UWF retinal mosaic
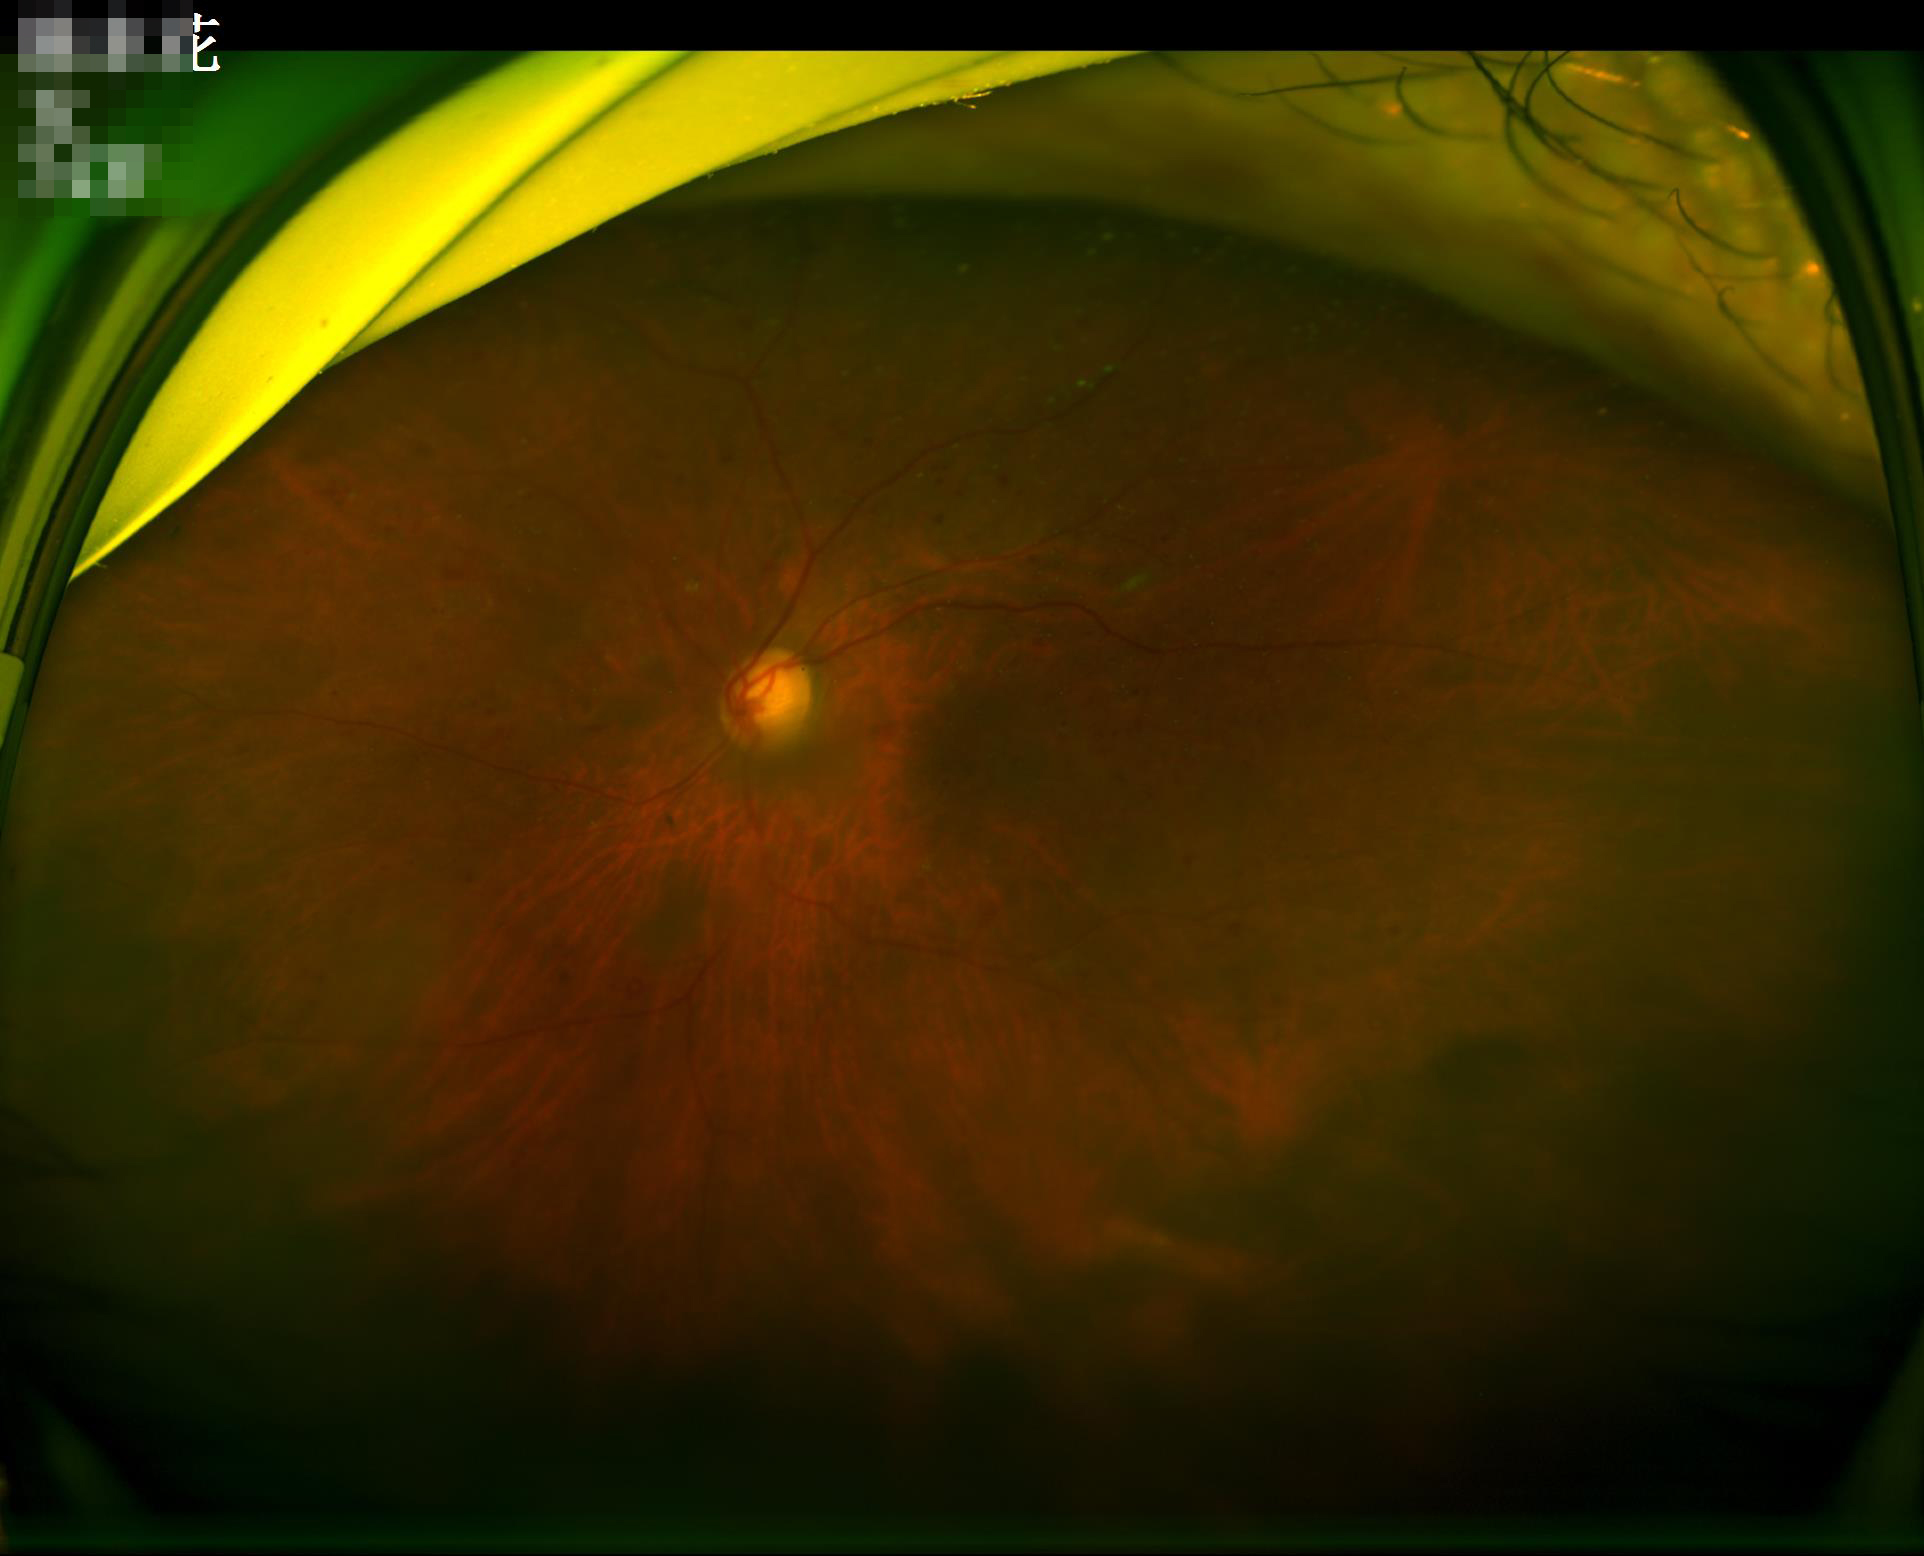 Illumination is uneven. Noticeable blur in the optic disc, vessels, or background. Vessels and details are readily distinguishable. Overall quality is poor; the image is difficult to grade.